Wide-field fundus image from infant ROP screening:
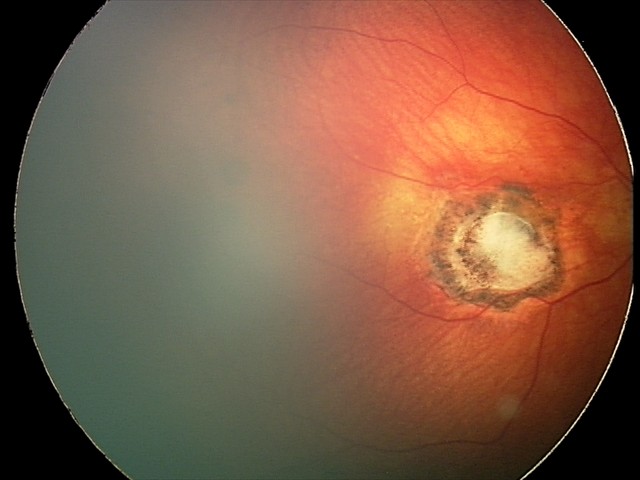 Screening examination consistent with toxoplasmosis chorioretinitis.